Without pupil dilation · modified Davis grading — 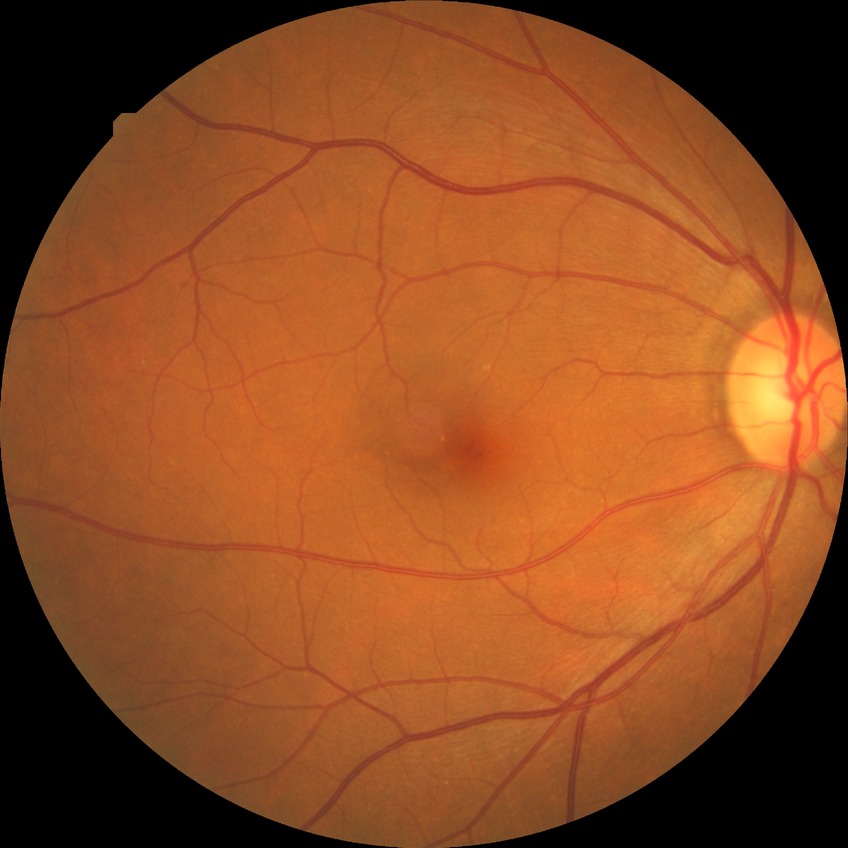
diabetic retinopathy (DR): no diabetic retinopathy (NDR).